45-degree field of view
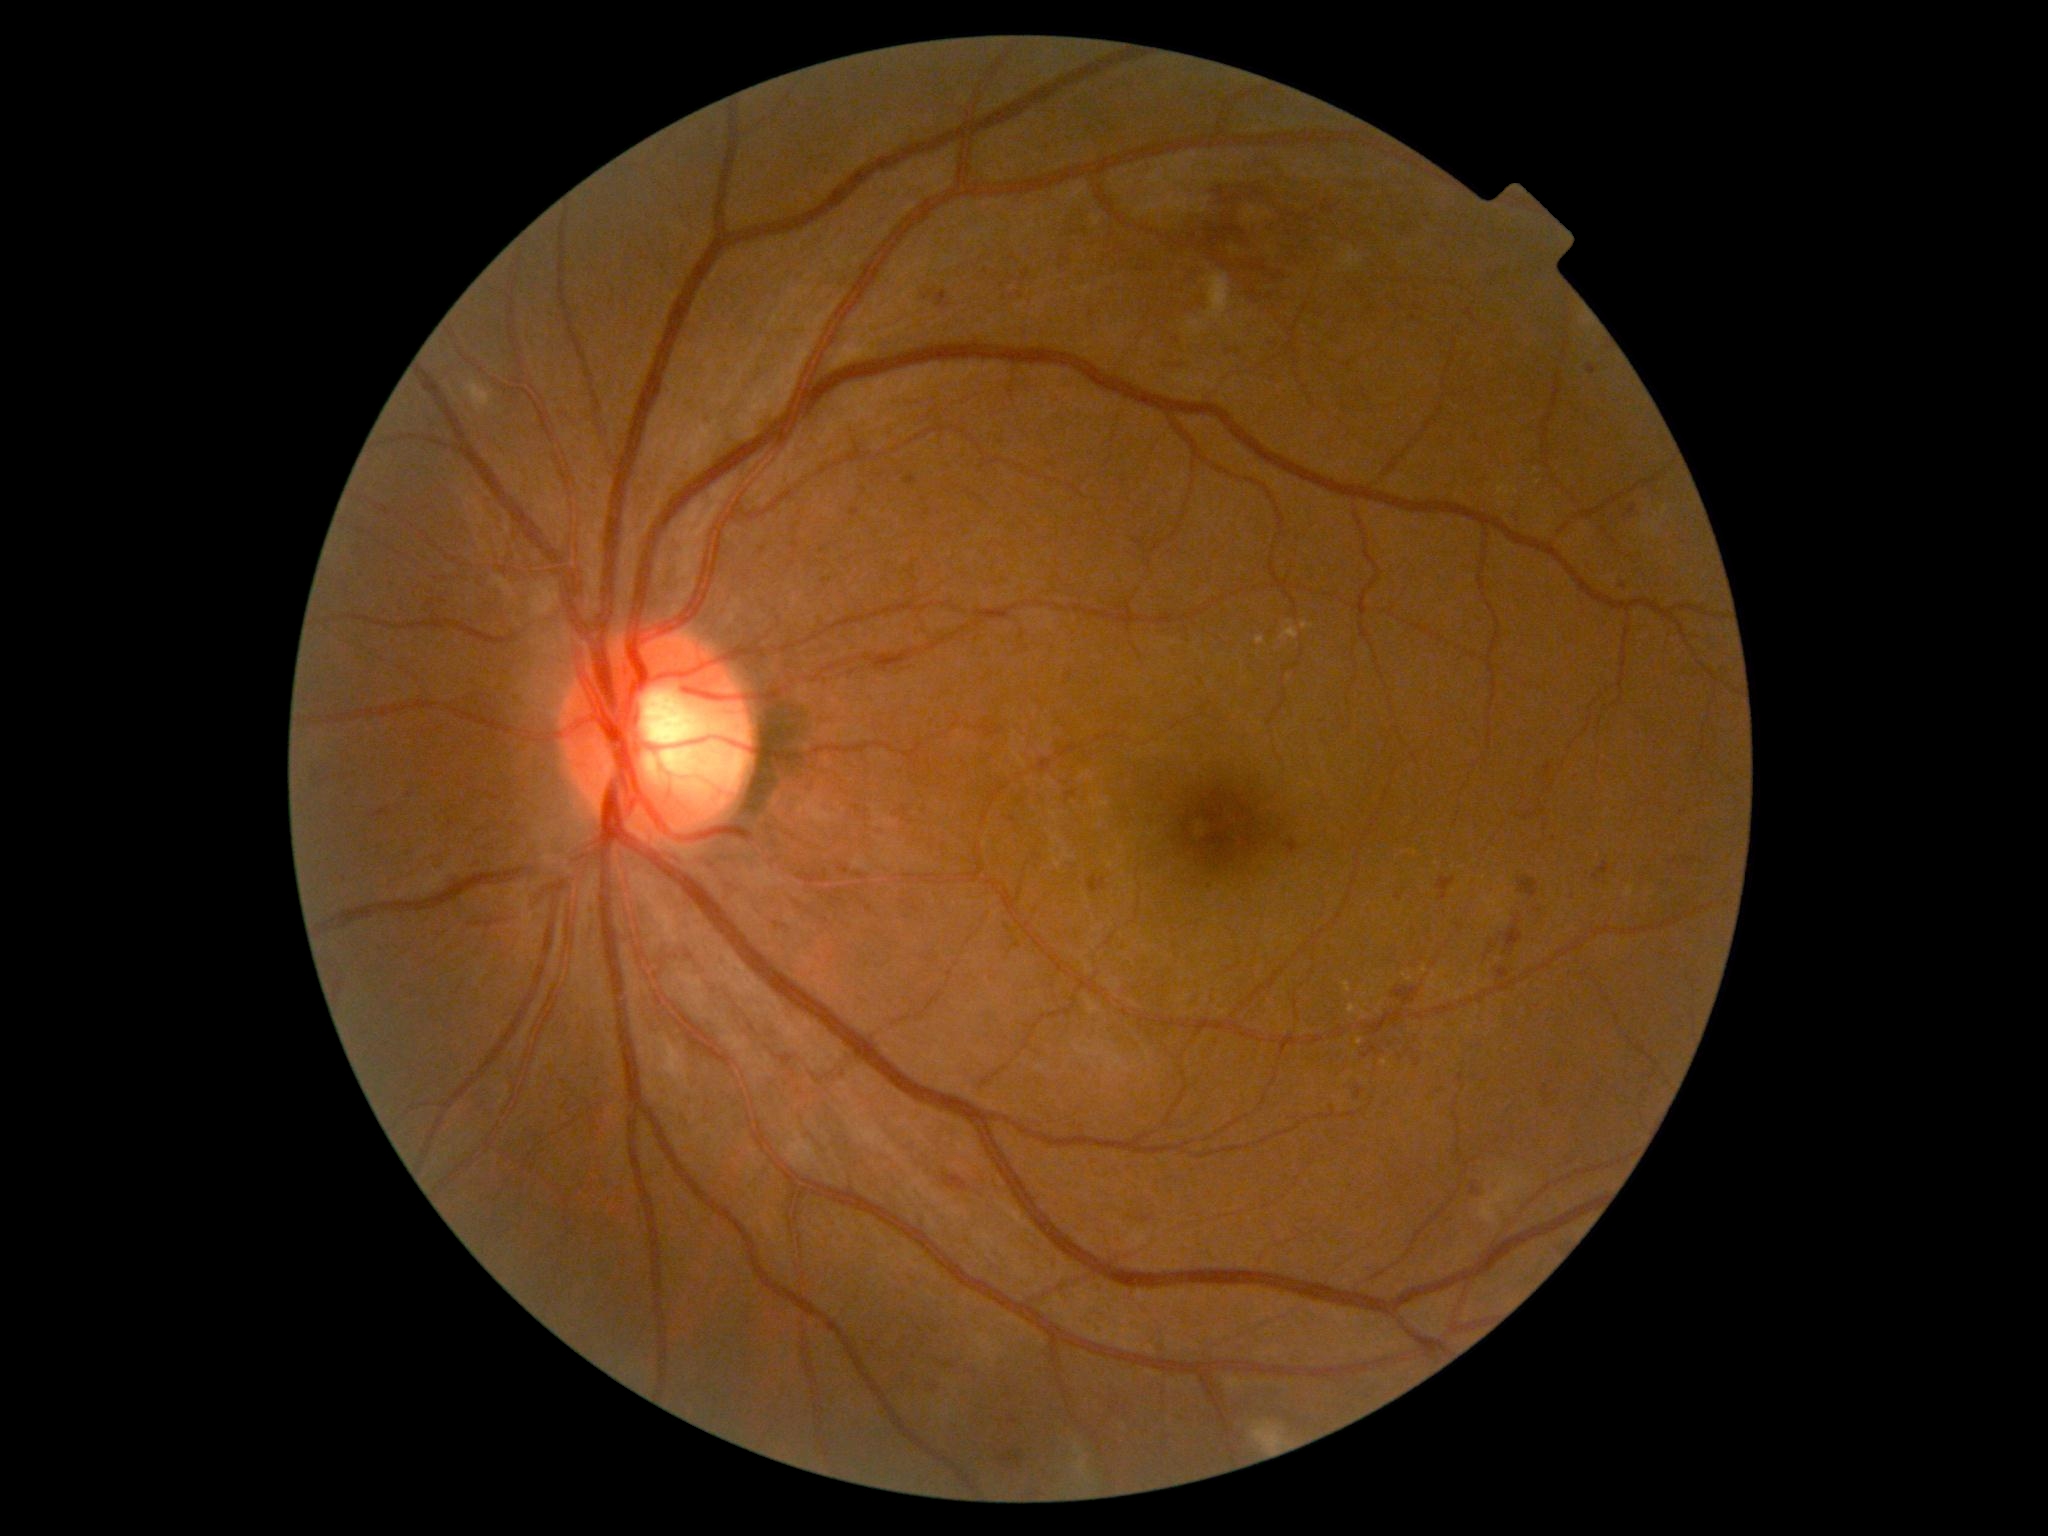
partial: true
dr_grade: 2
dr_grade_name: moderate NPDR
lesions:
  he:
    - BBox(1362, 1046, 1378, 1059)
    - BBox(1406, 315, 1416, 331)
    - BBox(1243, 155, 1288, 177)
    - BBox(1022, 271, 1030, 282)
    - BBox(1069, 225, 1089, 238)
    - BBox(943, 1174, 967, 1191)
    - BBox(1436, 877, 1456, 900)
    - BBox(315, 764, 329, 784)
    - BBox(1592, 861, 1609, 881)
    - BBox(1670, 858, 1678, 864)
    - BBox(1000, 1450, 1024, 1469)
    - BBox(1170, 178, 1296, 311)
    - BBox(1160, 359, 1187, 368)
    - BBox(1355, 1086, 1365, 1100)
    - BBox(1278, 221, 1339, 269)
    - BBox(1412, 301, 1425, 312)
    - BBox(1133, 261, 1159, 275)
    - BBox(1411, 285, 1425, 294)
  he_small_centers:
    - <point>931, 294</point>
    - <point>1693, 859</point>
  ex:
    - BBox(1498, 484, 1506, 495)
    - BBox(1302, 623, 1315, 630)
    - BBox(1349, 1004, 1358, 1014)
    - BBox(1343, 981, 1352, 993)
    - BBox(1256, 637, 1266, 645)
    - BBox(1280, 628, 1299, 641)
  ex_small_centers:
    - <point>1539, 483</point>
    - <point>1508, 494</point>
    - <point>1290, 622</point>
    - <point>1384, 1062</point>
    - <point>1290, 677</point>
    - <point>1359, 1042</point>
    - <point>1516, 491</point>
    - <point>1536, 471</point>
  se:
    - BBox(1253, 1422, 1286, 1451)
    - BBox(465, 379, 492, 412)
    - BBox(1341, 247, 1362, 268)
    - BBox(1076, 1459, 1087, 1475)
    - BBox(1206, 274, 1232, 320)
    - BBox(1478, 1174, 1521, 1223)
    - BBox(1186, 321, 1205, 334)
    - BBox(1074, 1444, 1084, 1455)
  ma:
    - BBox(1096, 1326, 1104, 1332)
    - BBox(1545, 763, 1554, 774)
    - BBox(1545, 1093, 1552, 1104)
    - BBox(1395, 893, 1402, 901)
    - BBox(1225, 349, 1233, 357)
    - BBox(904, 475, 917, 485)
    - BBox(1456, 1073, 1465, 1083)
  ma_small_centers:
    - <point>822, 551</point>
    - <point>1573, 897</point>
    - <point>905, 902</point>
    - <point>869, 909</point>
    - <point>1546, 1088</point>
    - <point>477, 864</point>
    - <point>1647, 1091</point>
    - <point>1013, 820</point>